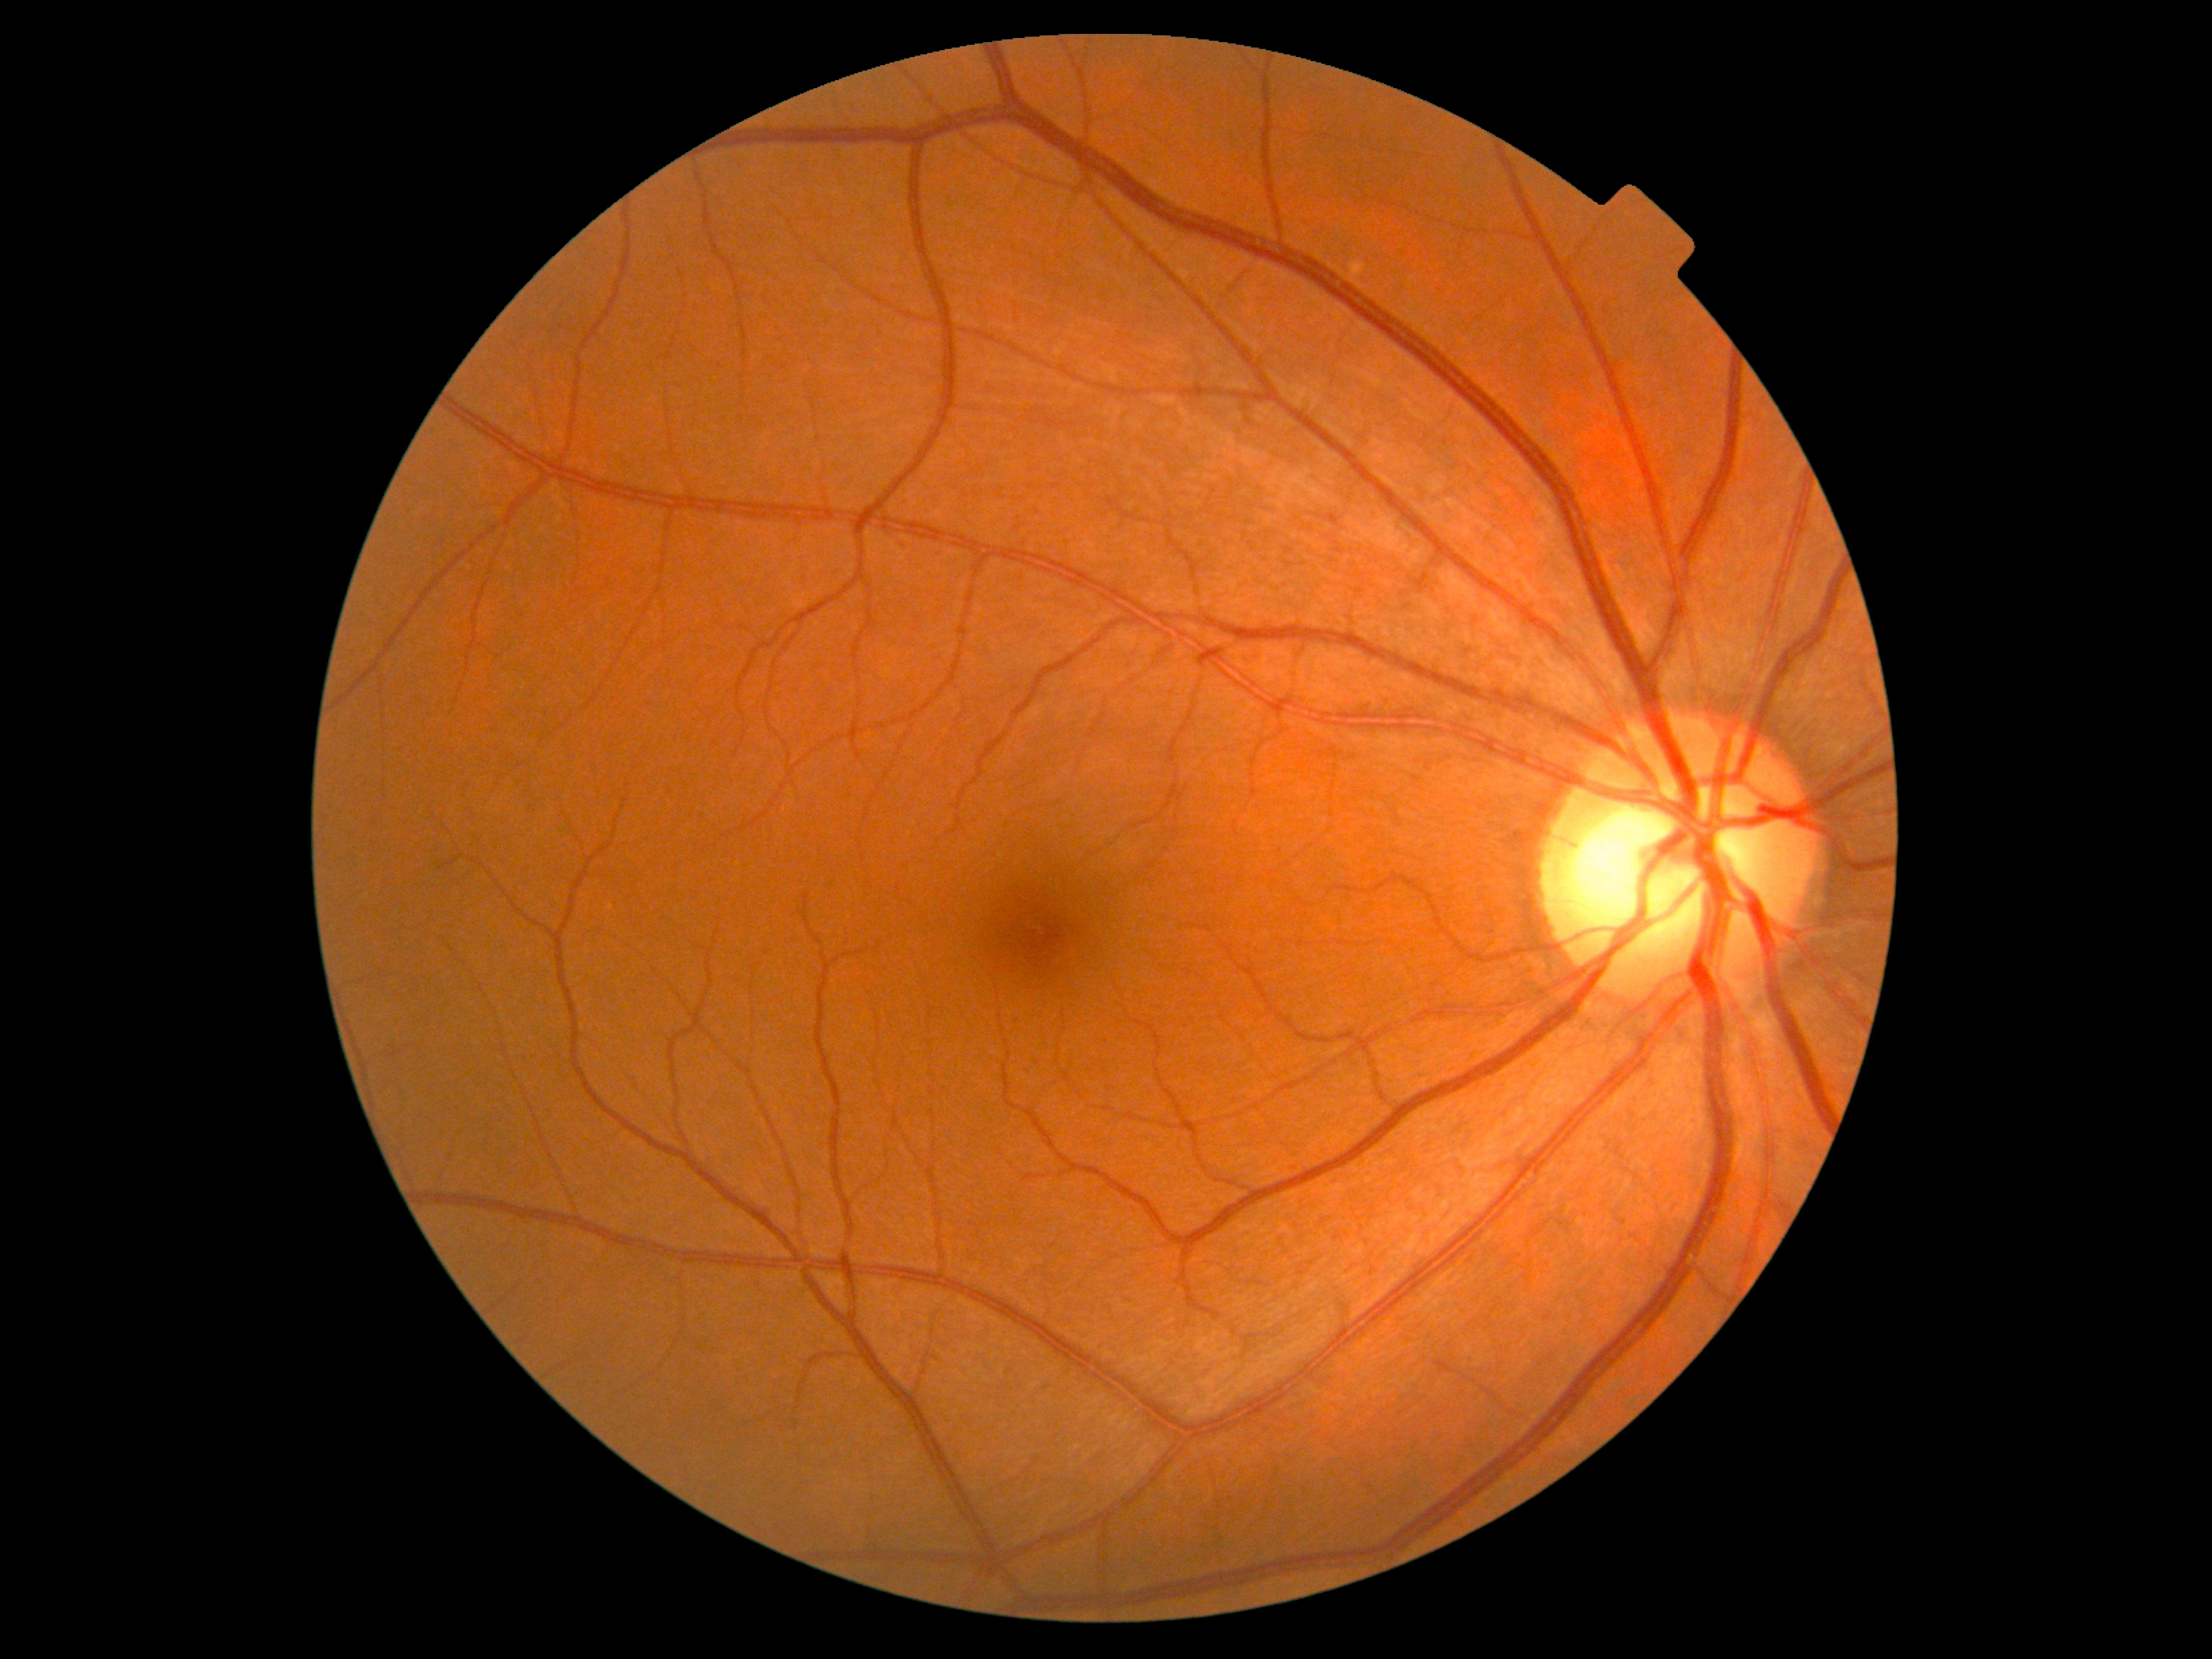 DR severity: no apparent retinopathy (grade 0)
DR impression: no apparent DR